Image size 2352x1568. CFP.
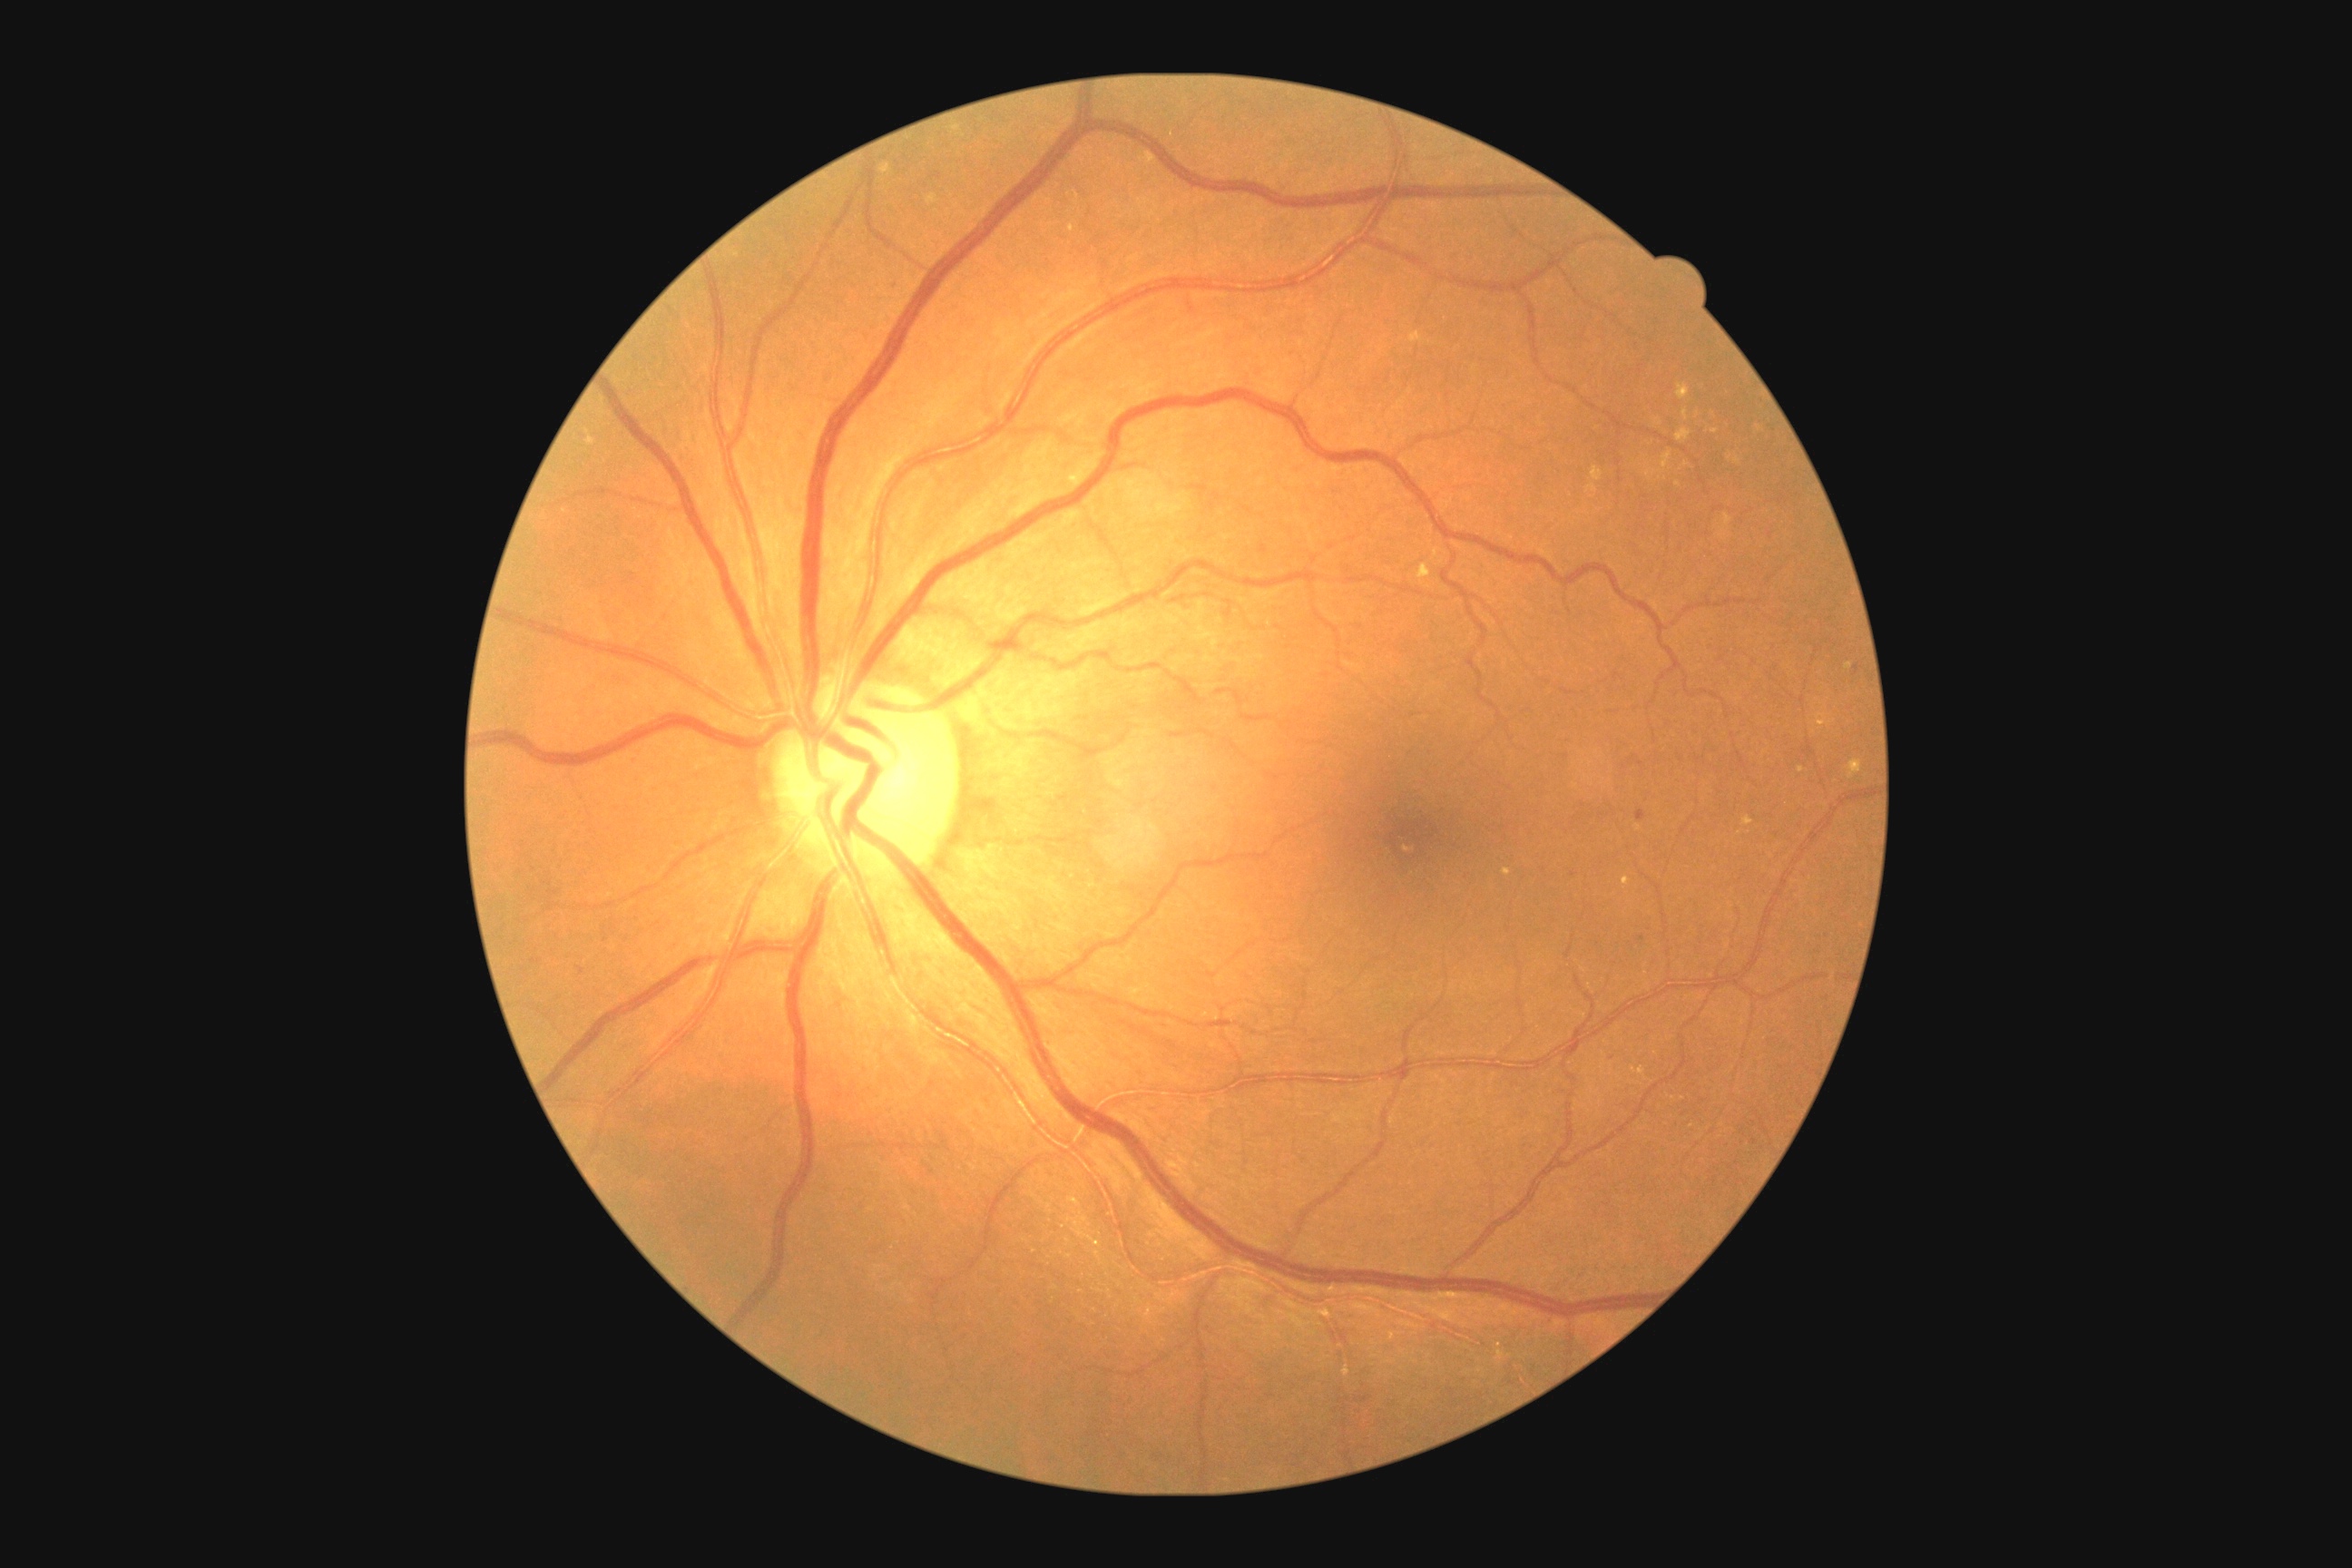 DR grade: 2 (moderate NPDR)
Selected lesions:
EXs (continued) = (1647, 469, 1656, 480) | (1683, 409, 1689, 420) | (1411, 333, 1424, 342) | (1725, 514, 1732, 527) | (1592, 467, 1603, 482) | (1678, 384, 1690, 400) | (926, 195, 939, 206) | (1587, 485, 1598, 493) | (1623, 877, 1631, 887) | (1734, 458, 1741, 466) | (1141, 153, 1157, 166) | (1676, 429, 1692, 444)
Small EXs approximately at (1639, 828) | (1674, 1099) | (1692, 1126) | (1729, 459) | (1678, 484) | (1802, 770)